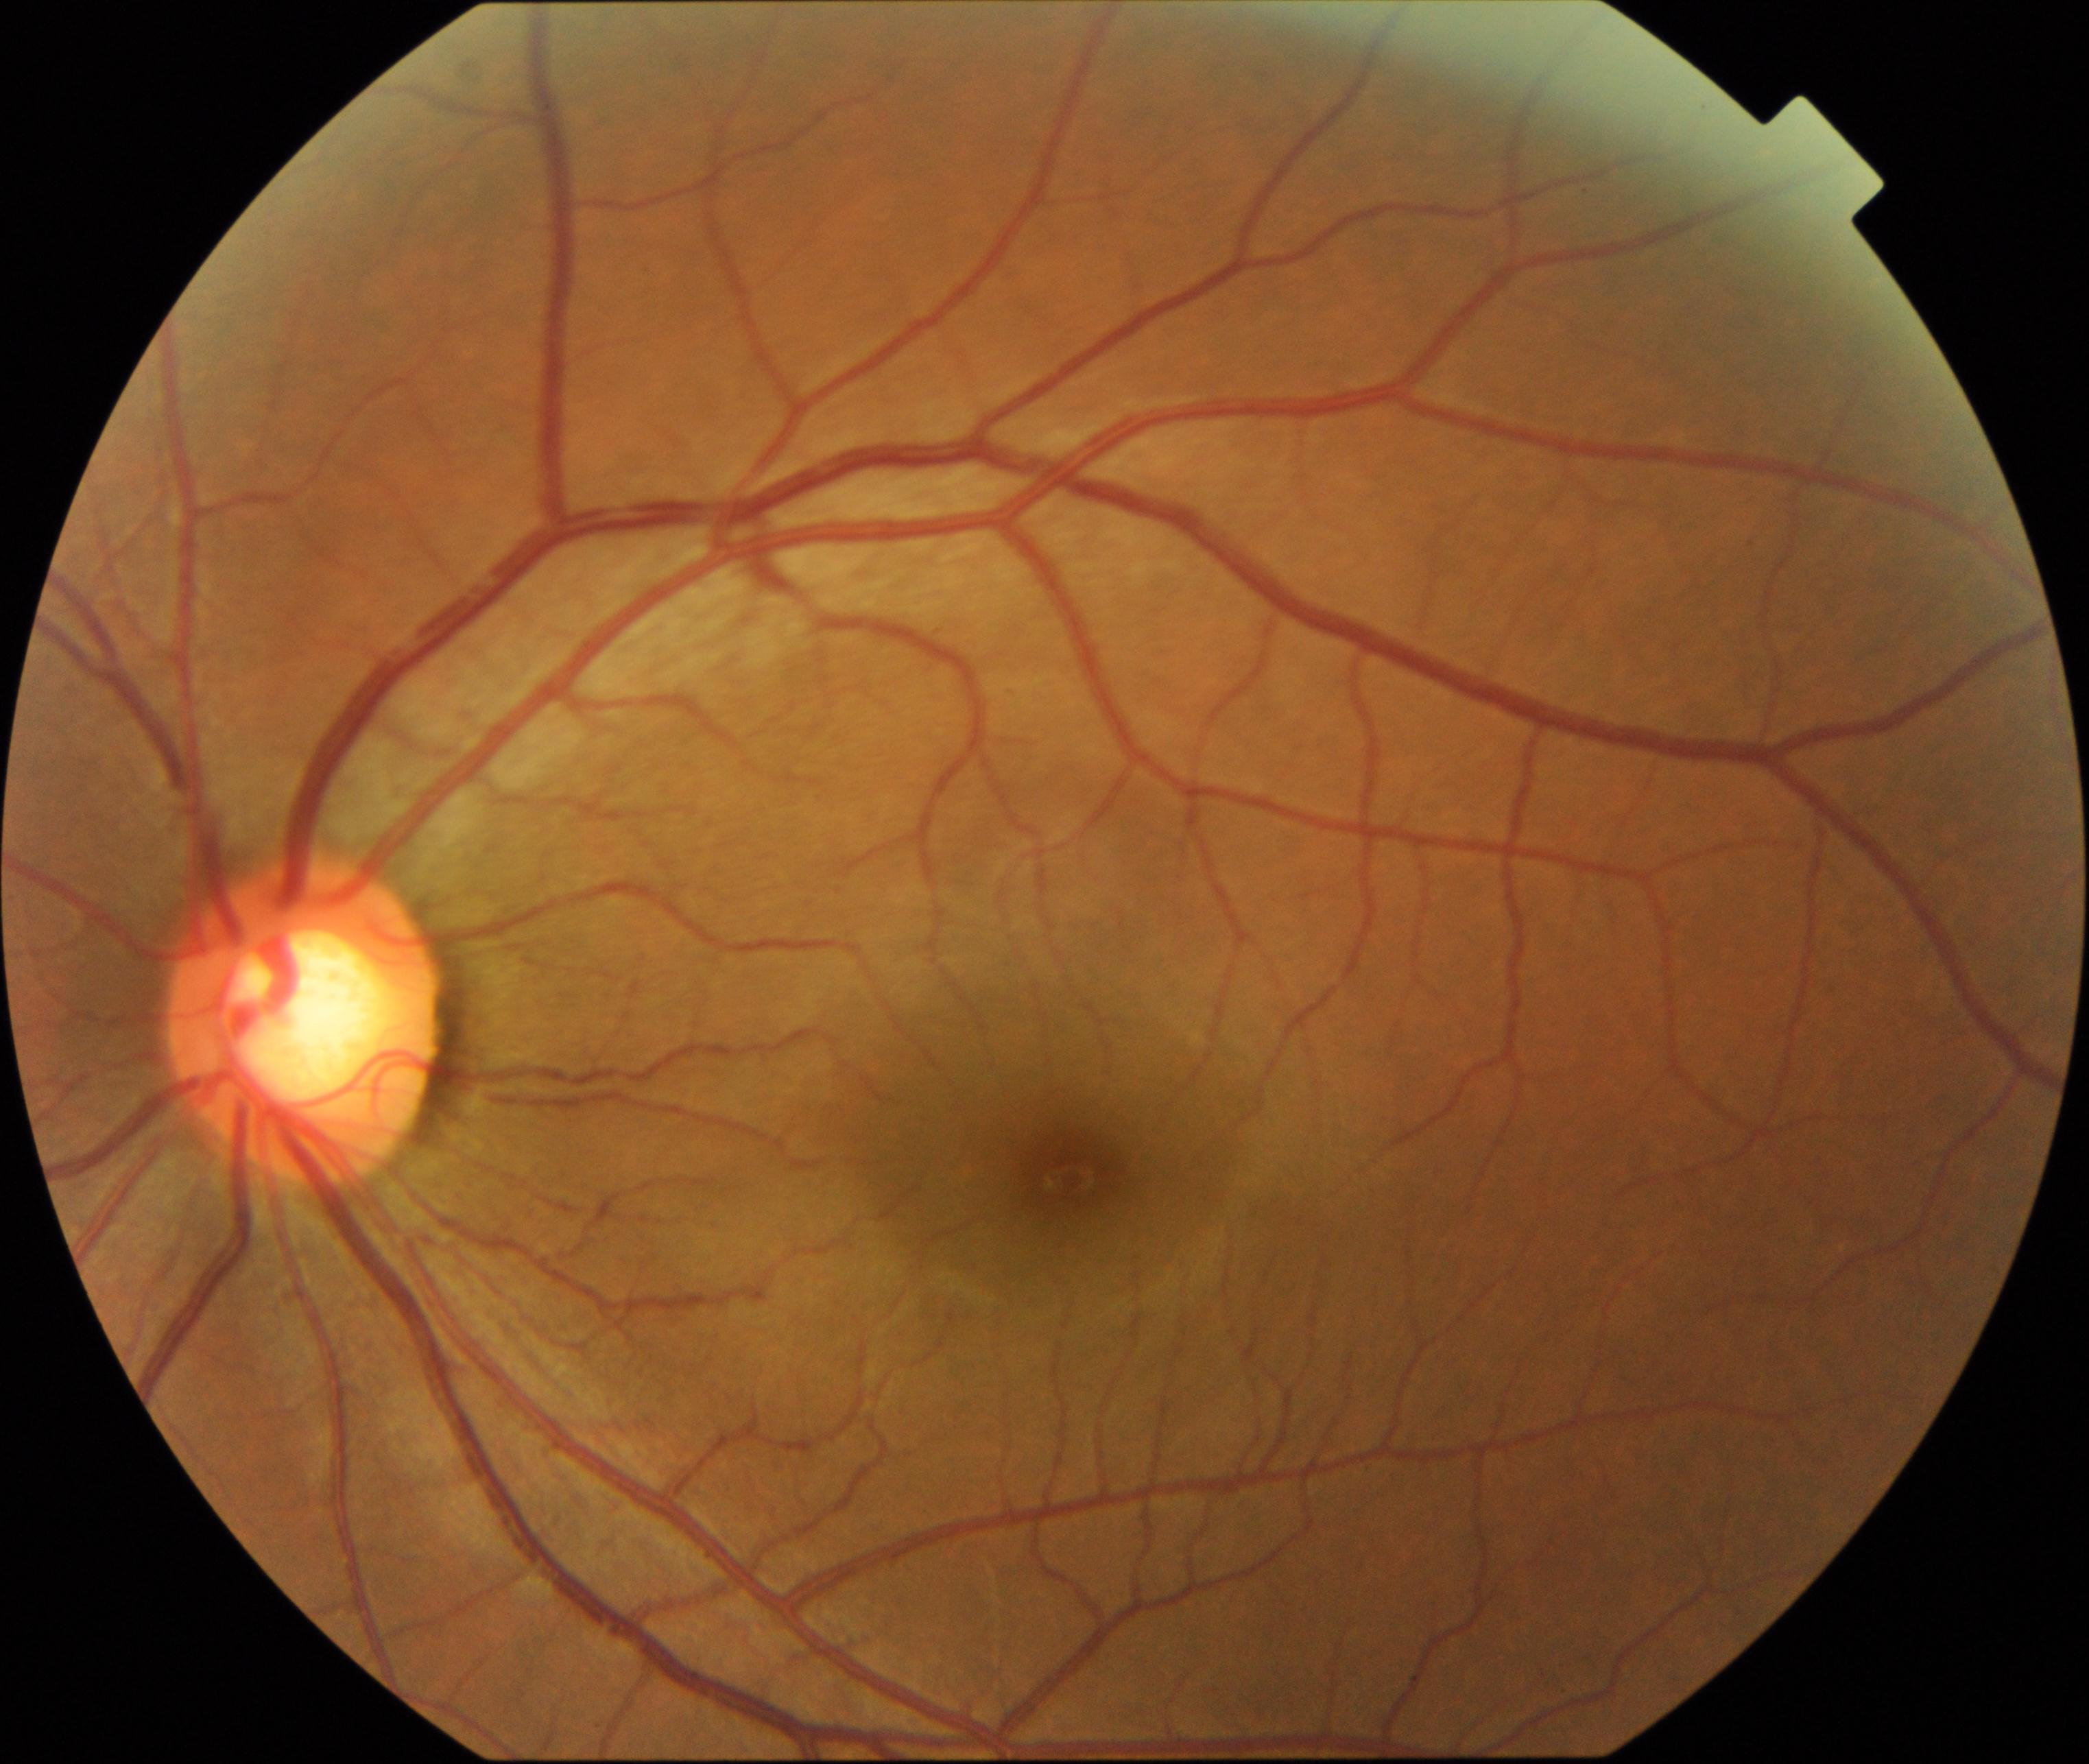
Classification: large optic cup.